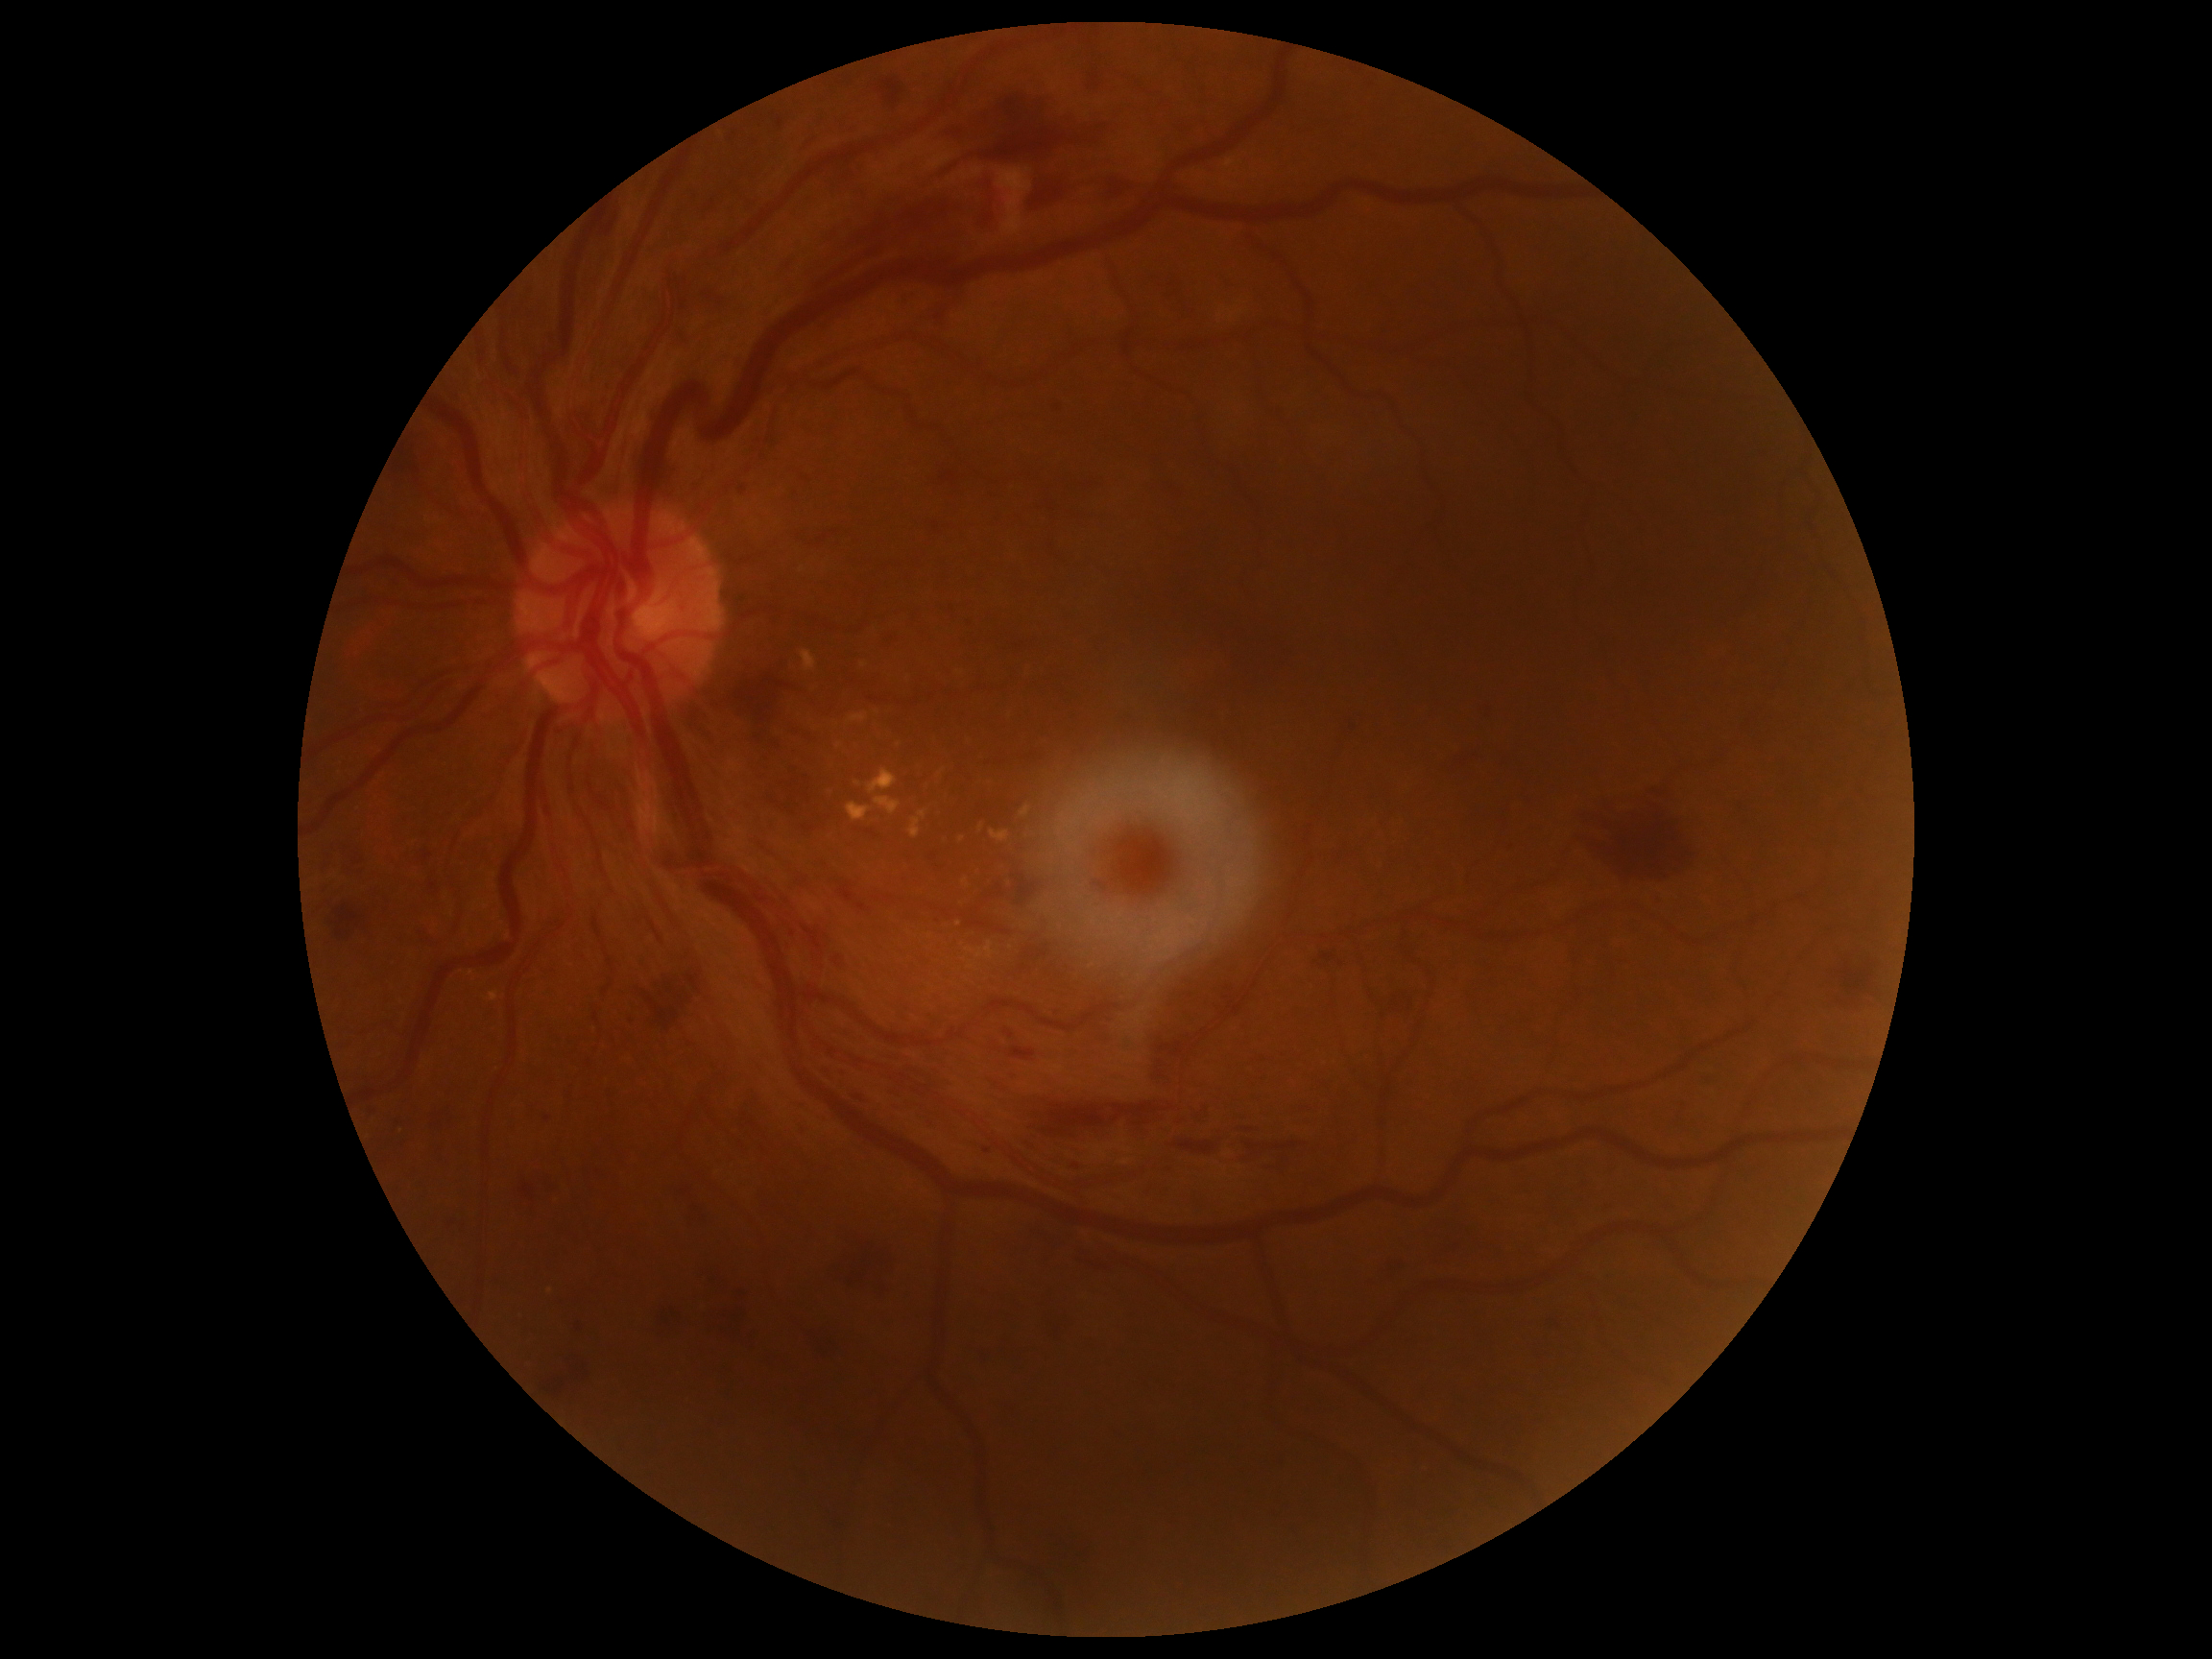

Findings:
- diabetic retinopathy — moderate non-proliferative diabetic retinopathy (grade 2) — more than just microaneurysms but less than severe NPDR